Fundus photo. FOV: 45 degrees. 2352 x 1568 pixels:
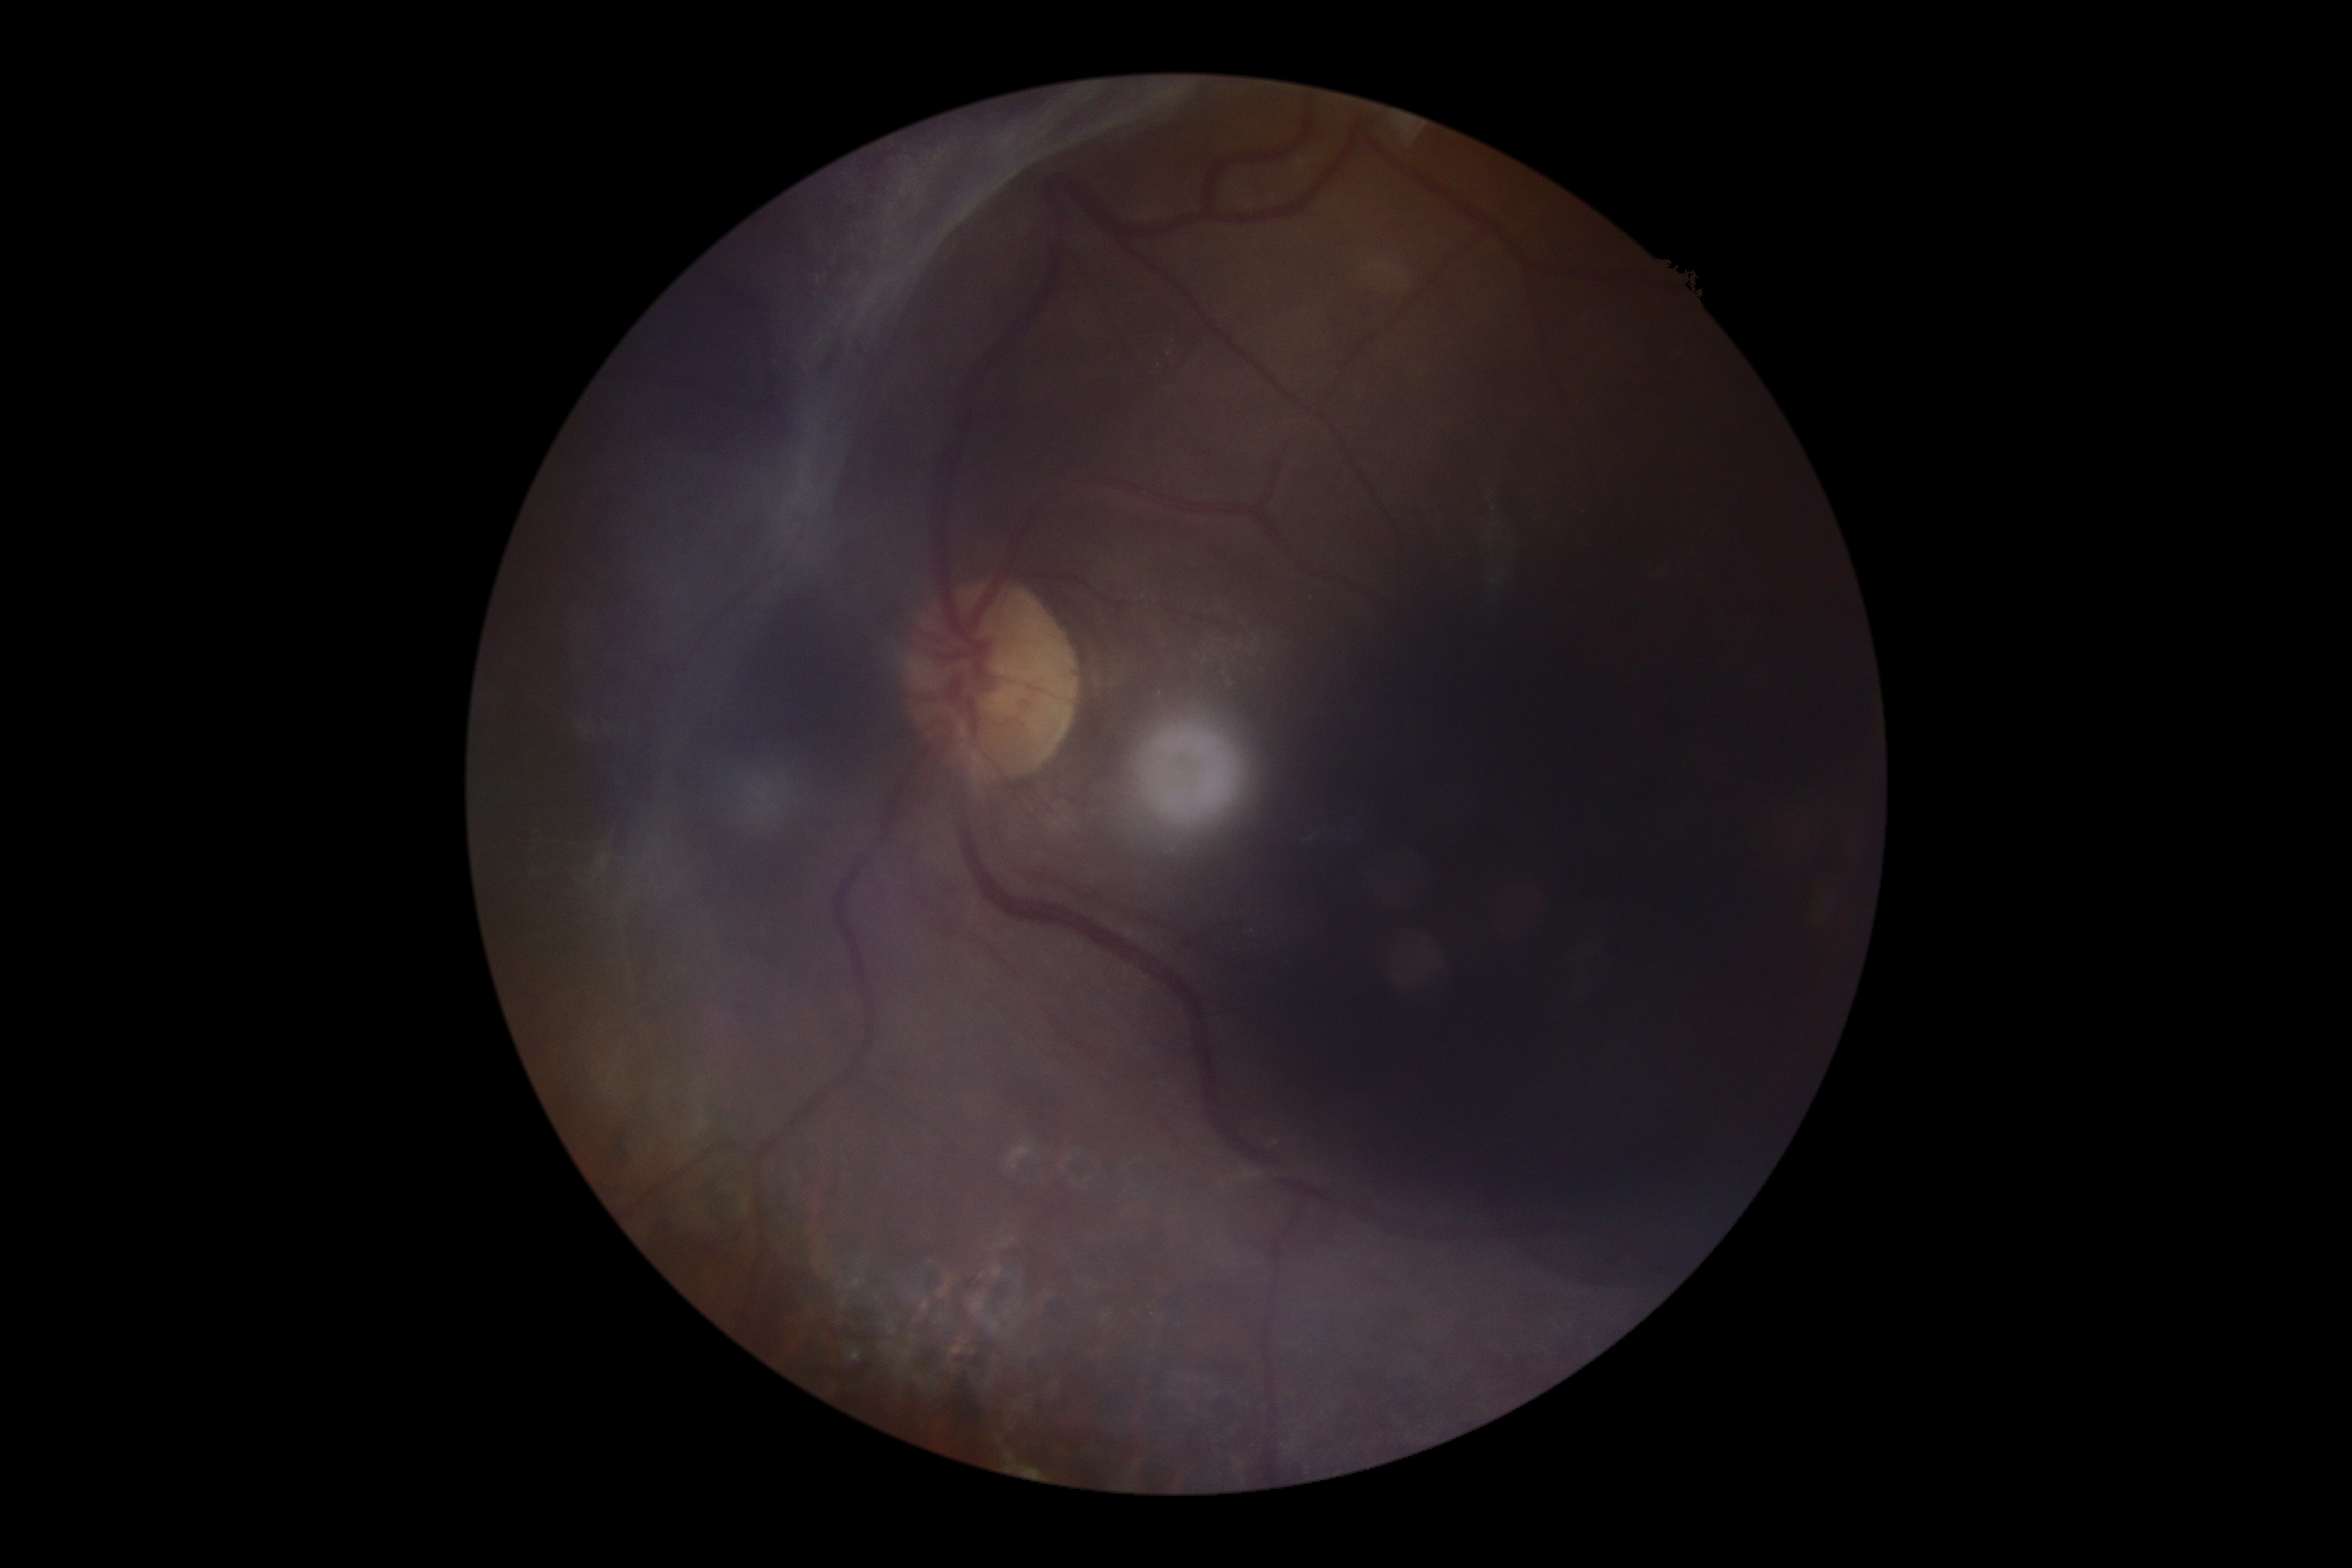 Diabetic retinopathy (DR): grade 4.